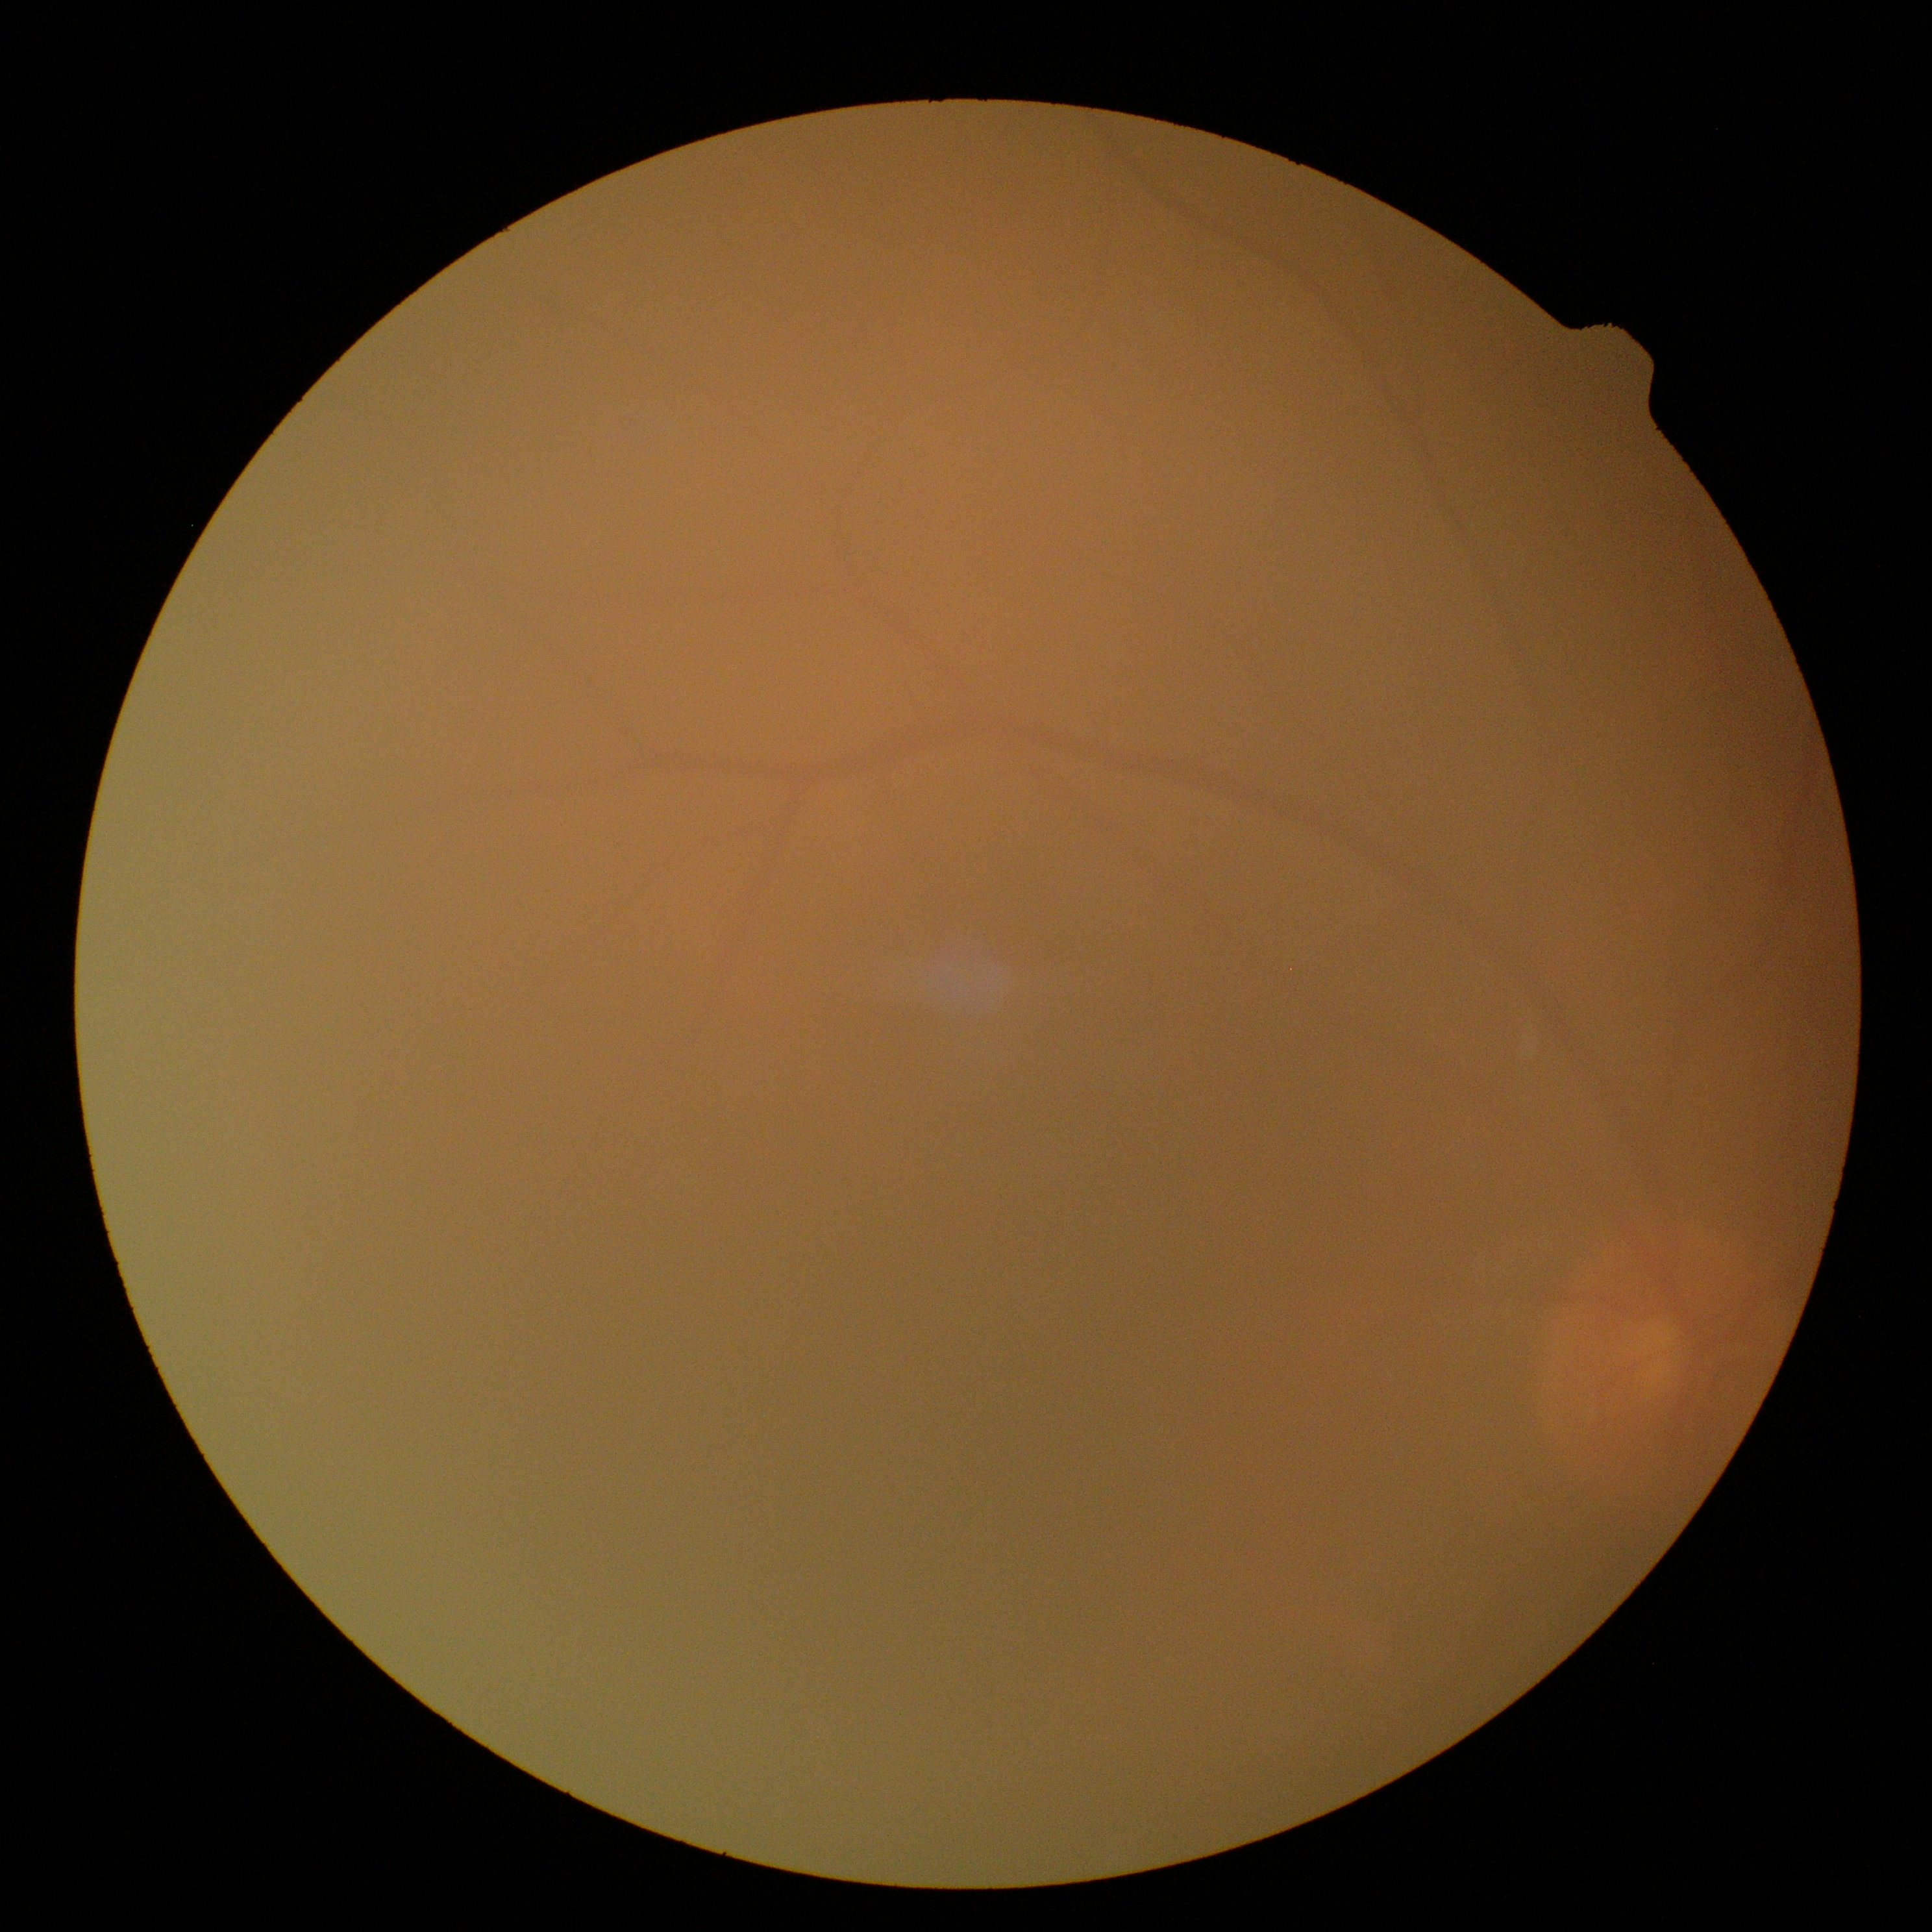 - retinopathy grade — ungradable